Wide-field fundus image from infant ROP screening:
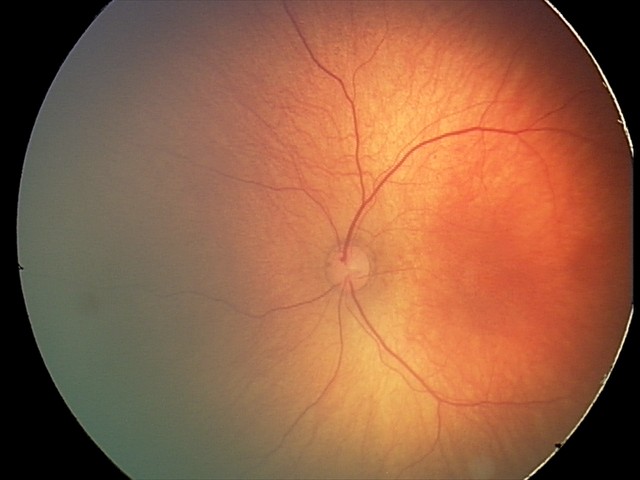 Assessment = normal.